Wide-field contact fundus photograph of an infant; camera: Clarity RetCam 3 (130° FOV) — 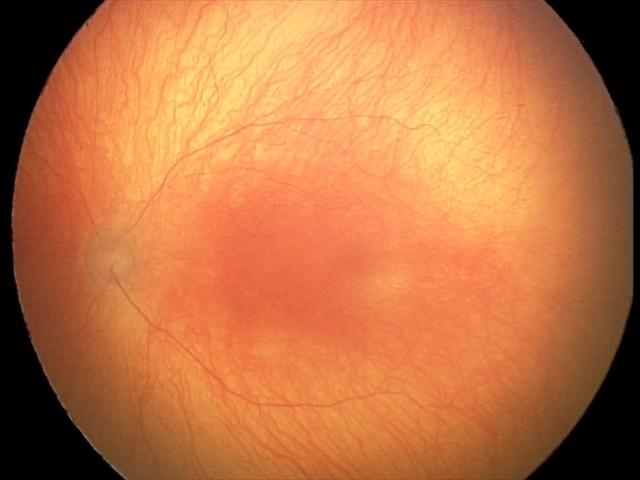 Screening diagnosis: aggressive ROP (A-ROP).